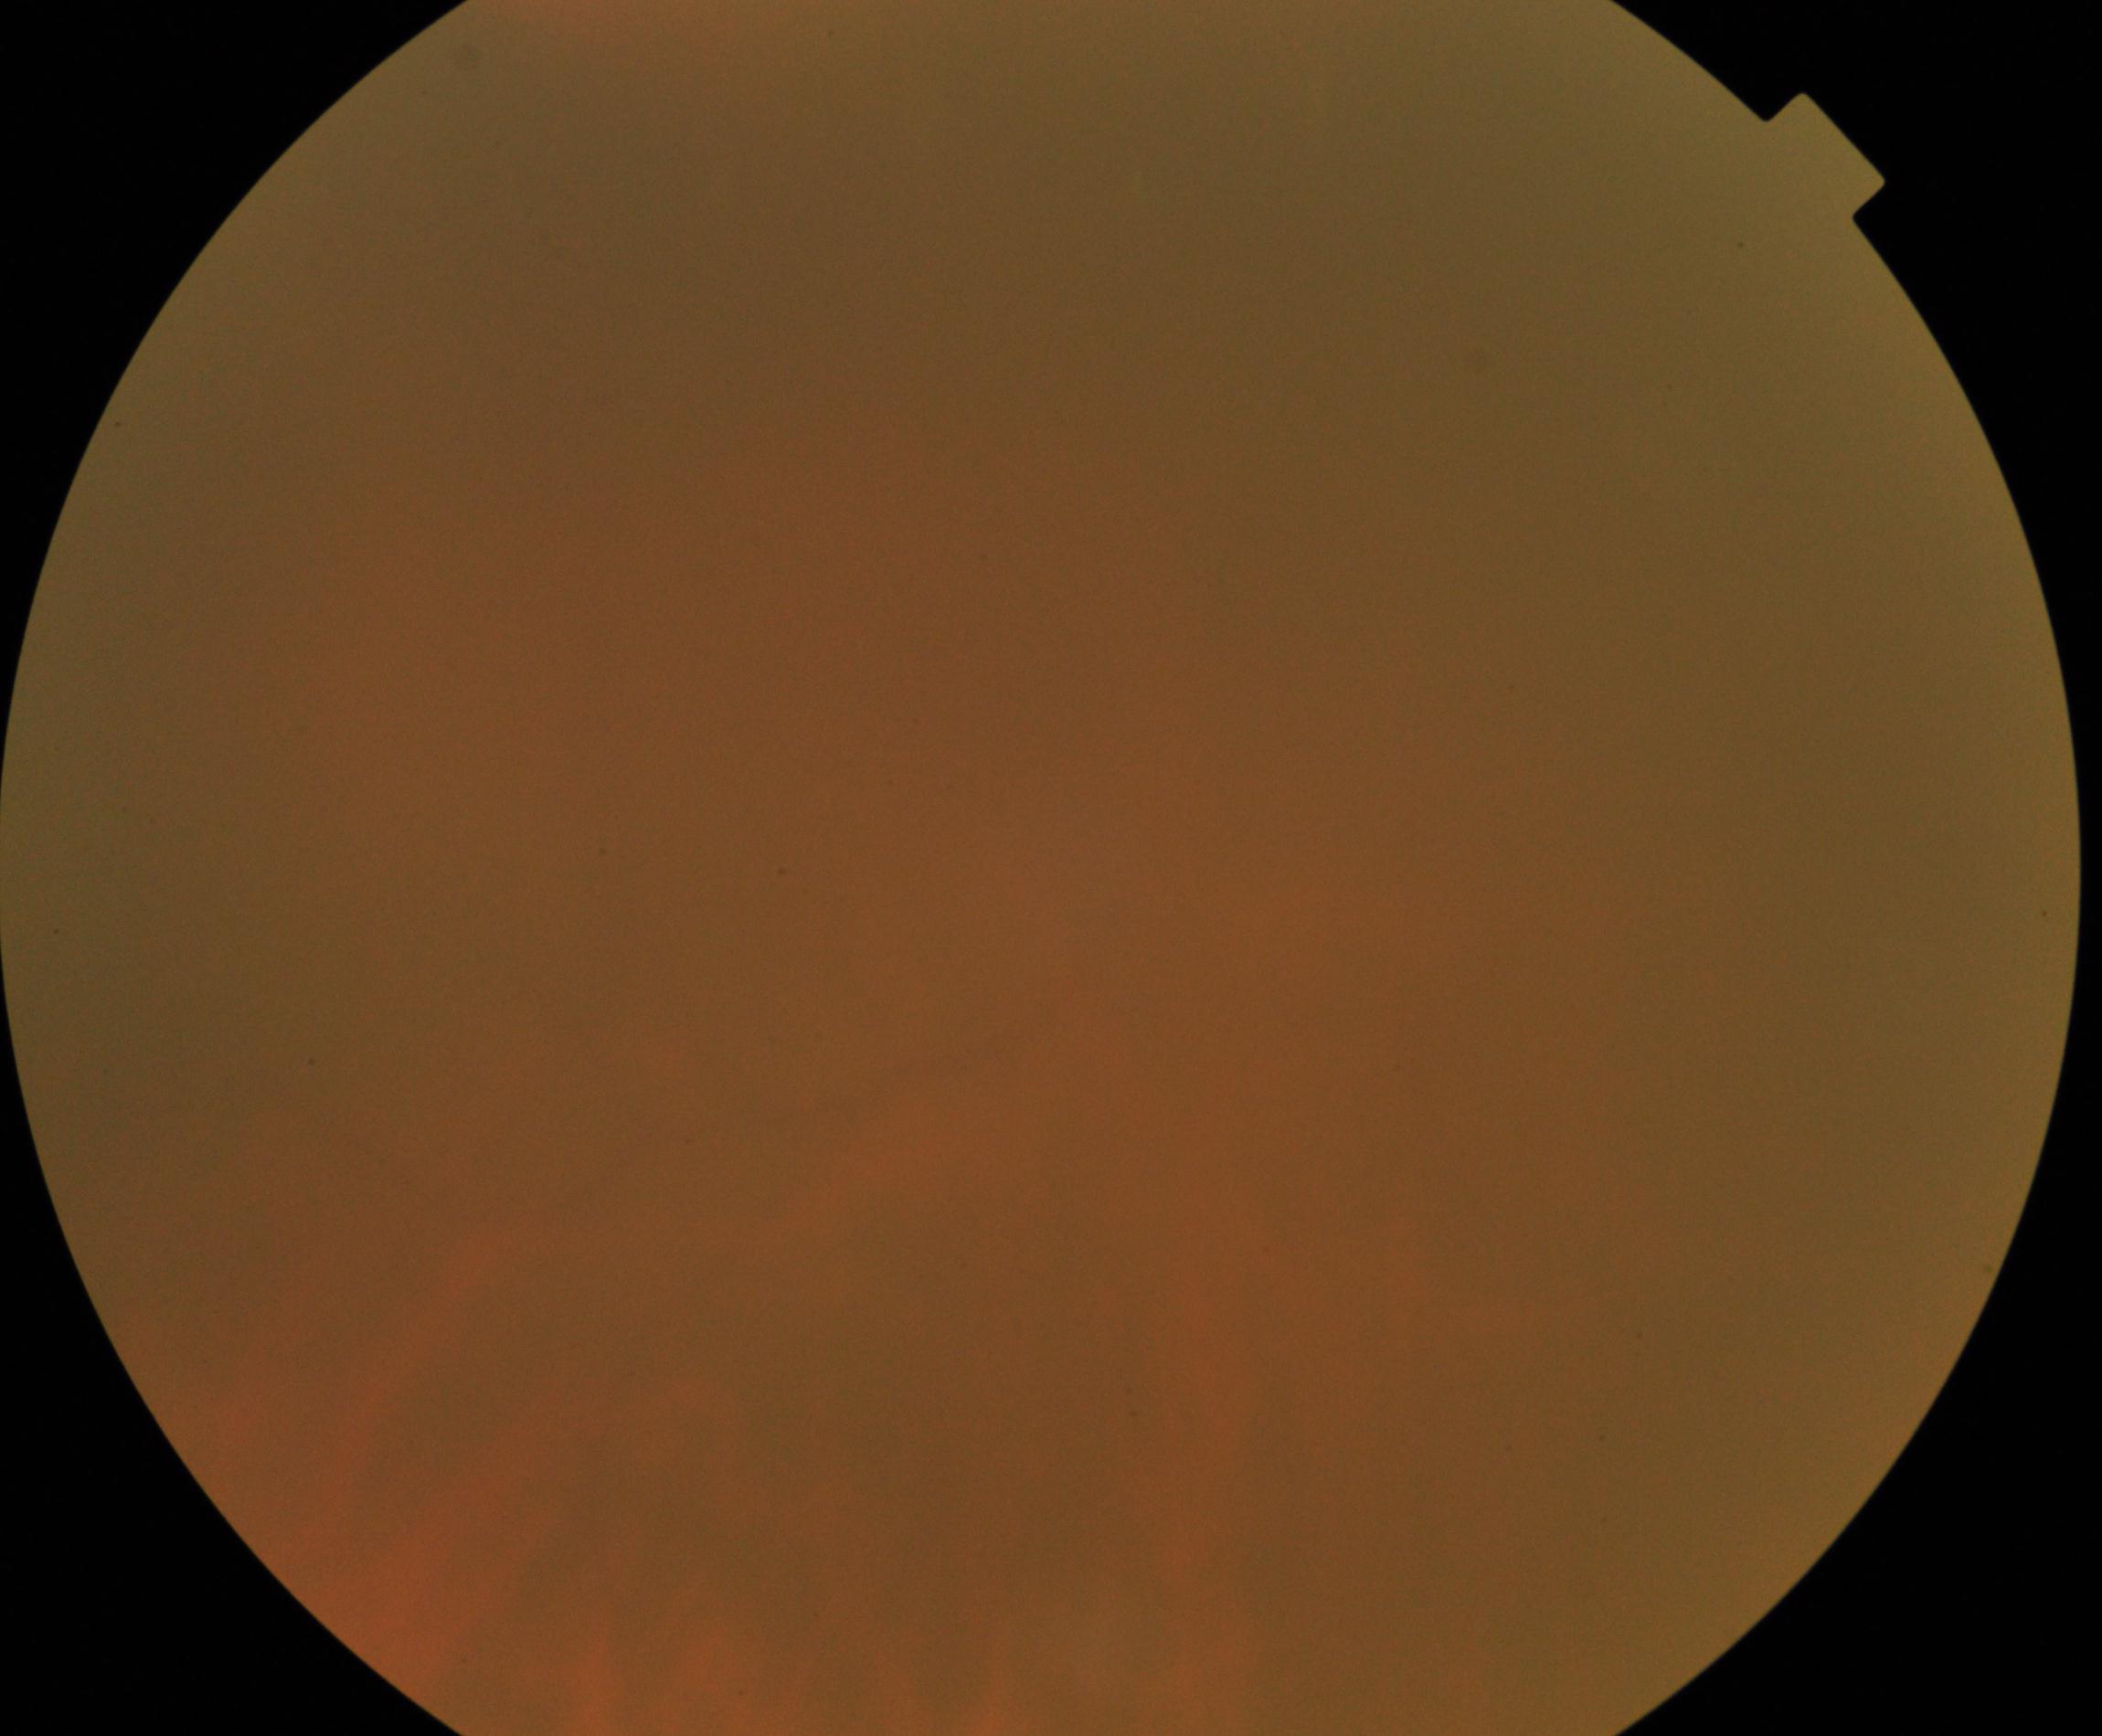 Image quality: poor.
Proliferative retinopathy: not identified.